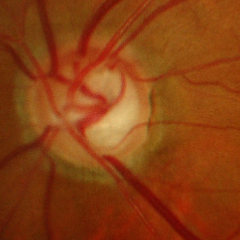

Optic disc photograph demonstrating severe glaucomatous damage.